CFP
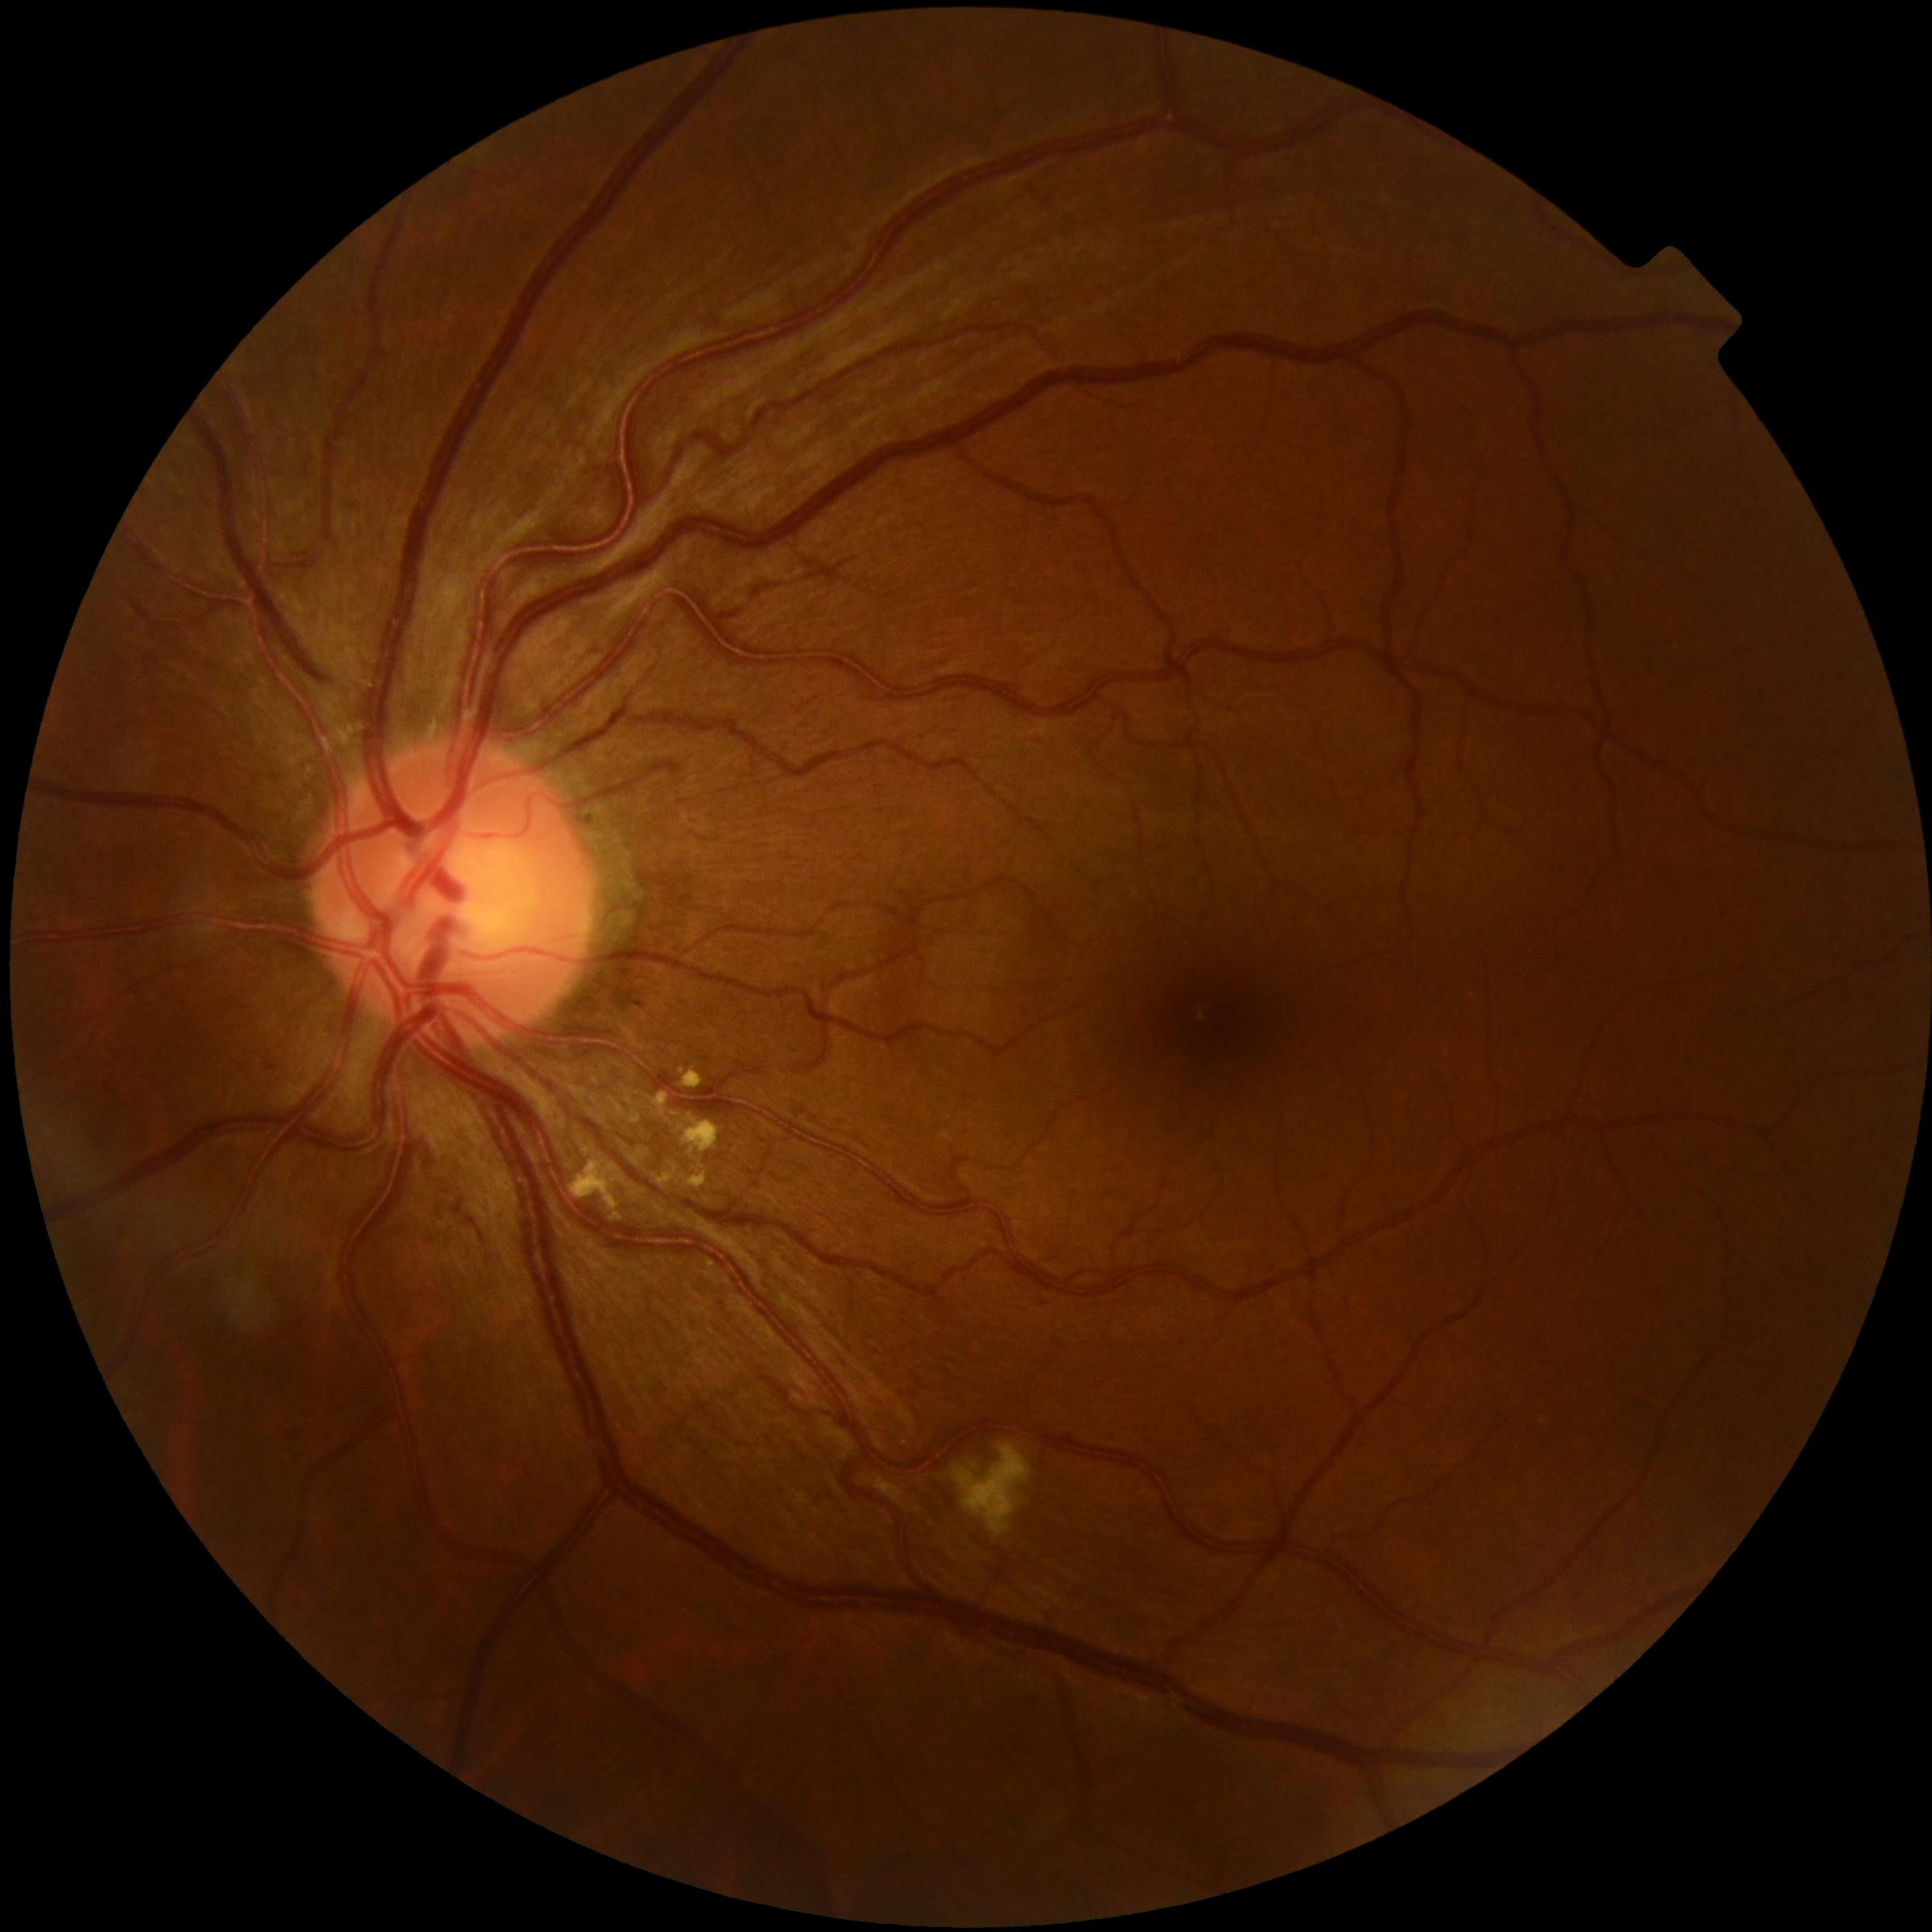 * diabetic retinopathy — moderate non-proliferative diabetic retinopathy (grade 2)